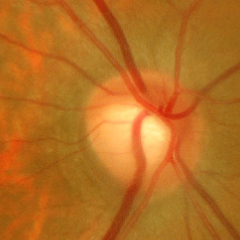

There is evidence of early glaucoma.